Wide-field fundus image from infant ROP screening.
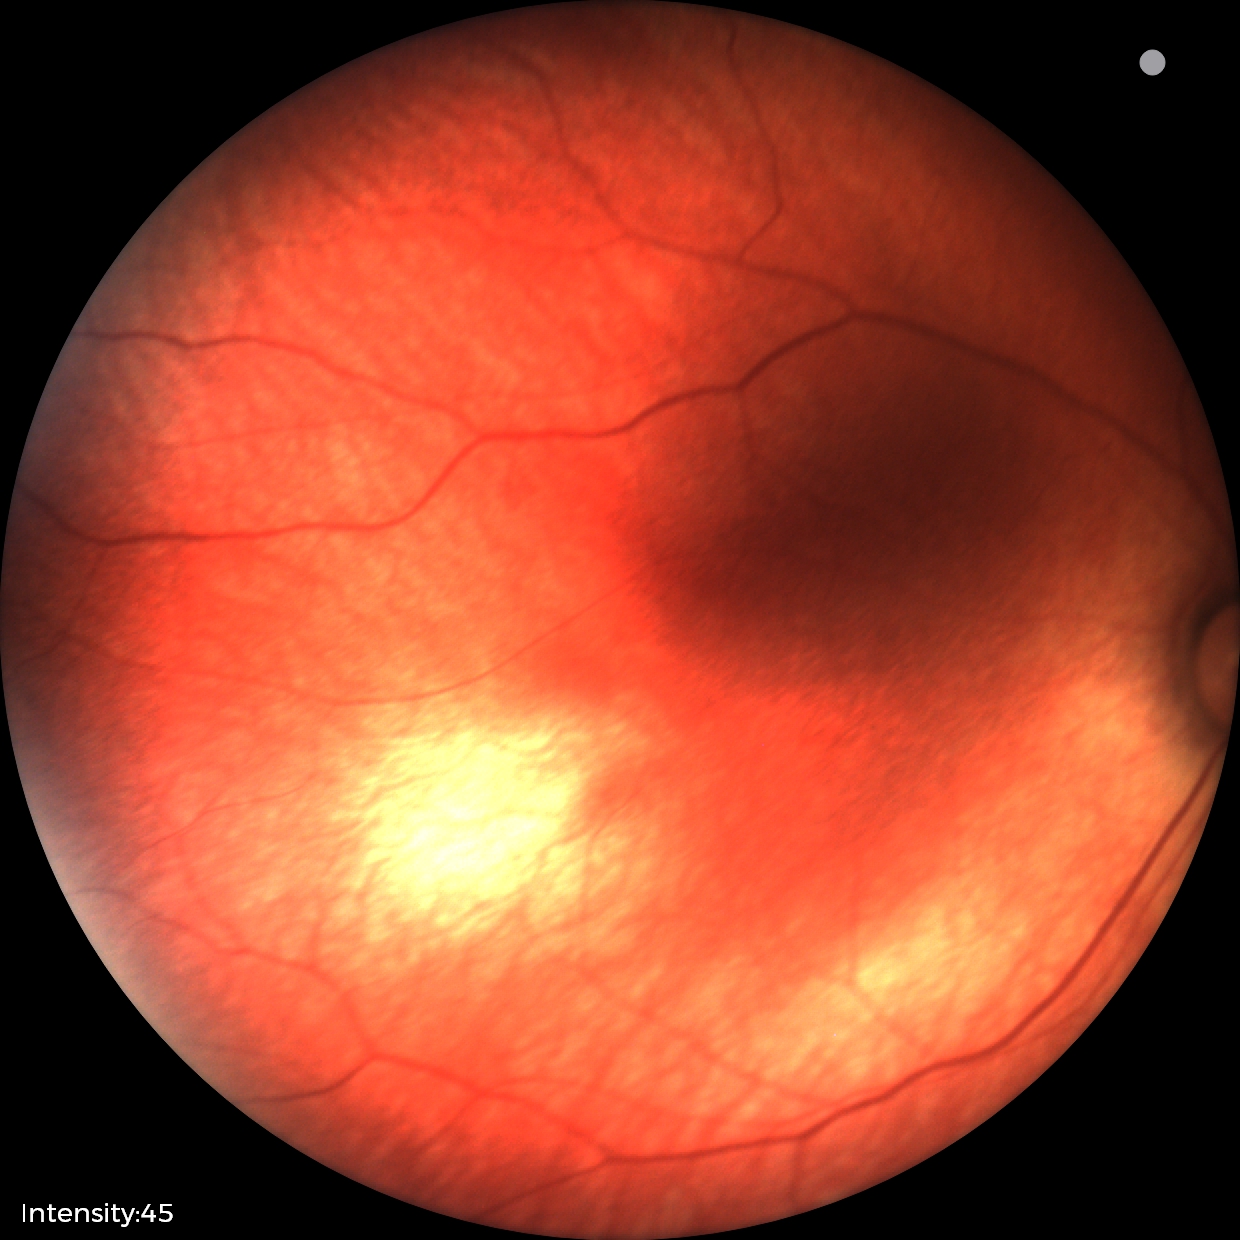 Impression = physiological appearance